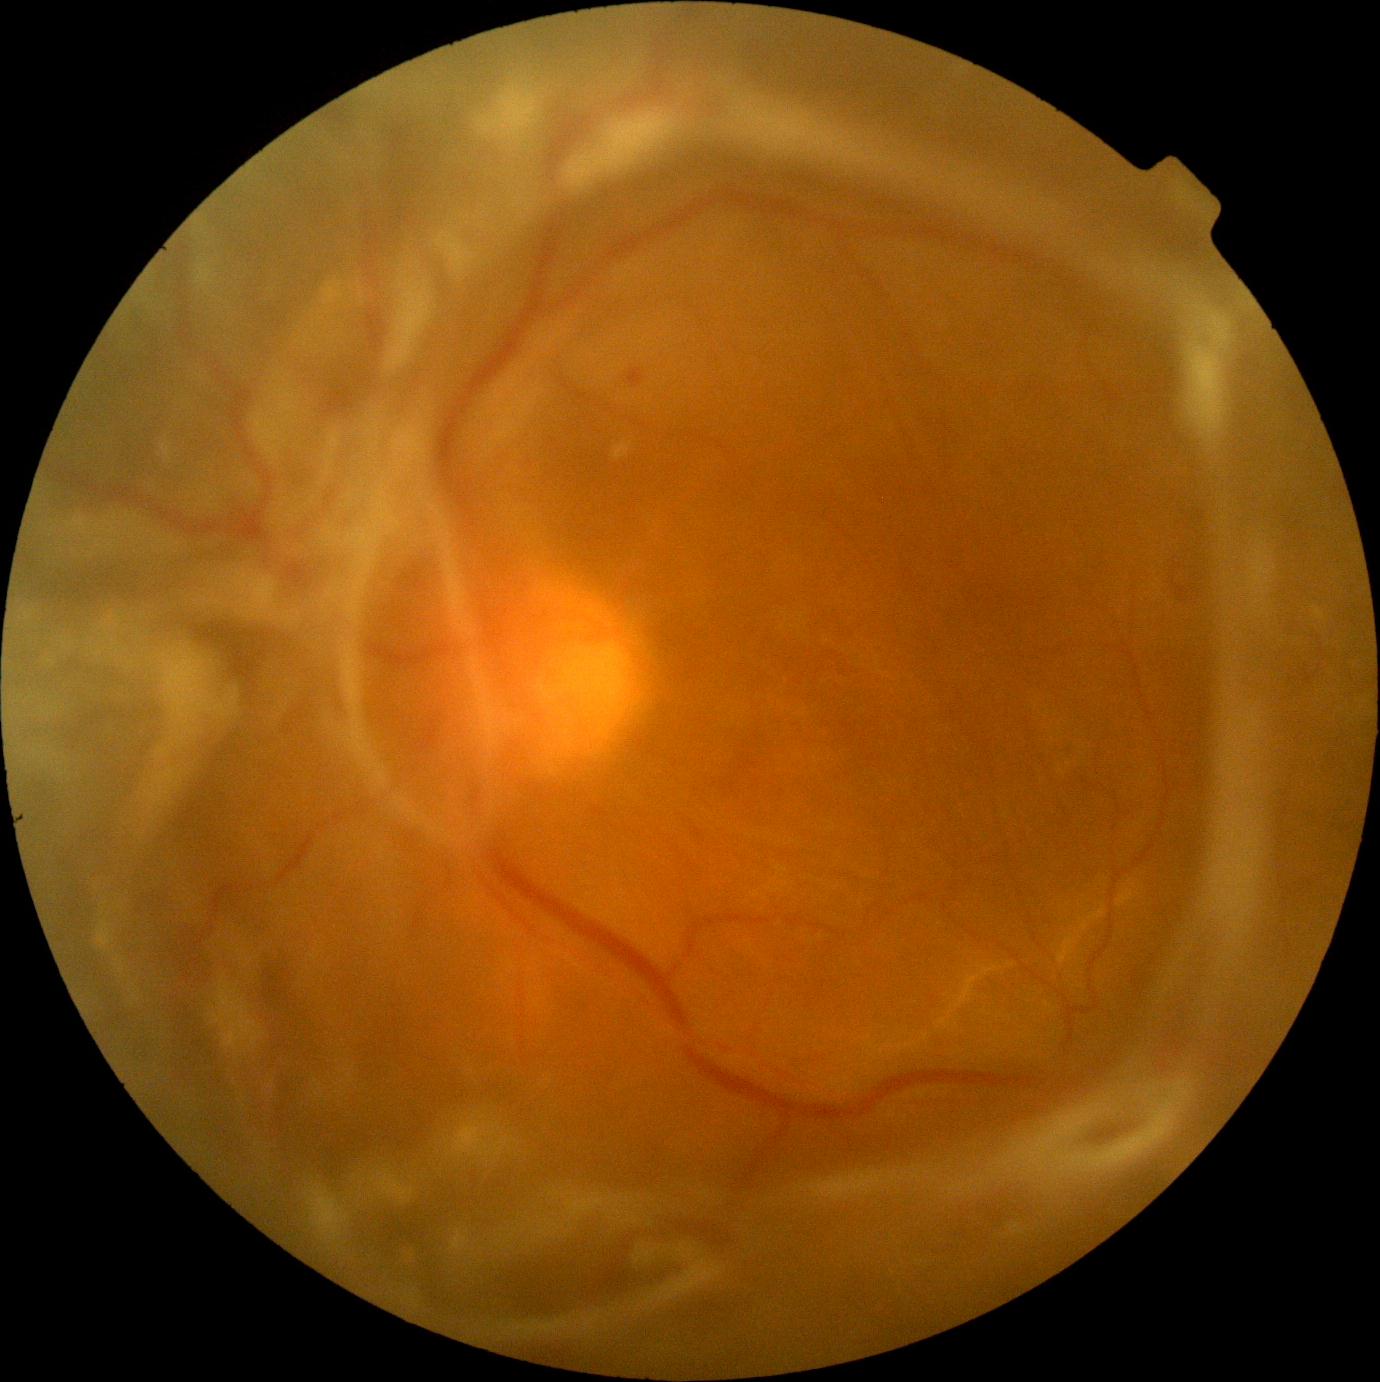
DR class = proliferative diabetic retinopathy | DR stage = PDR (grade 4).